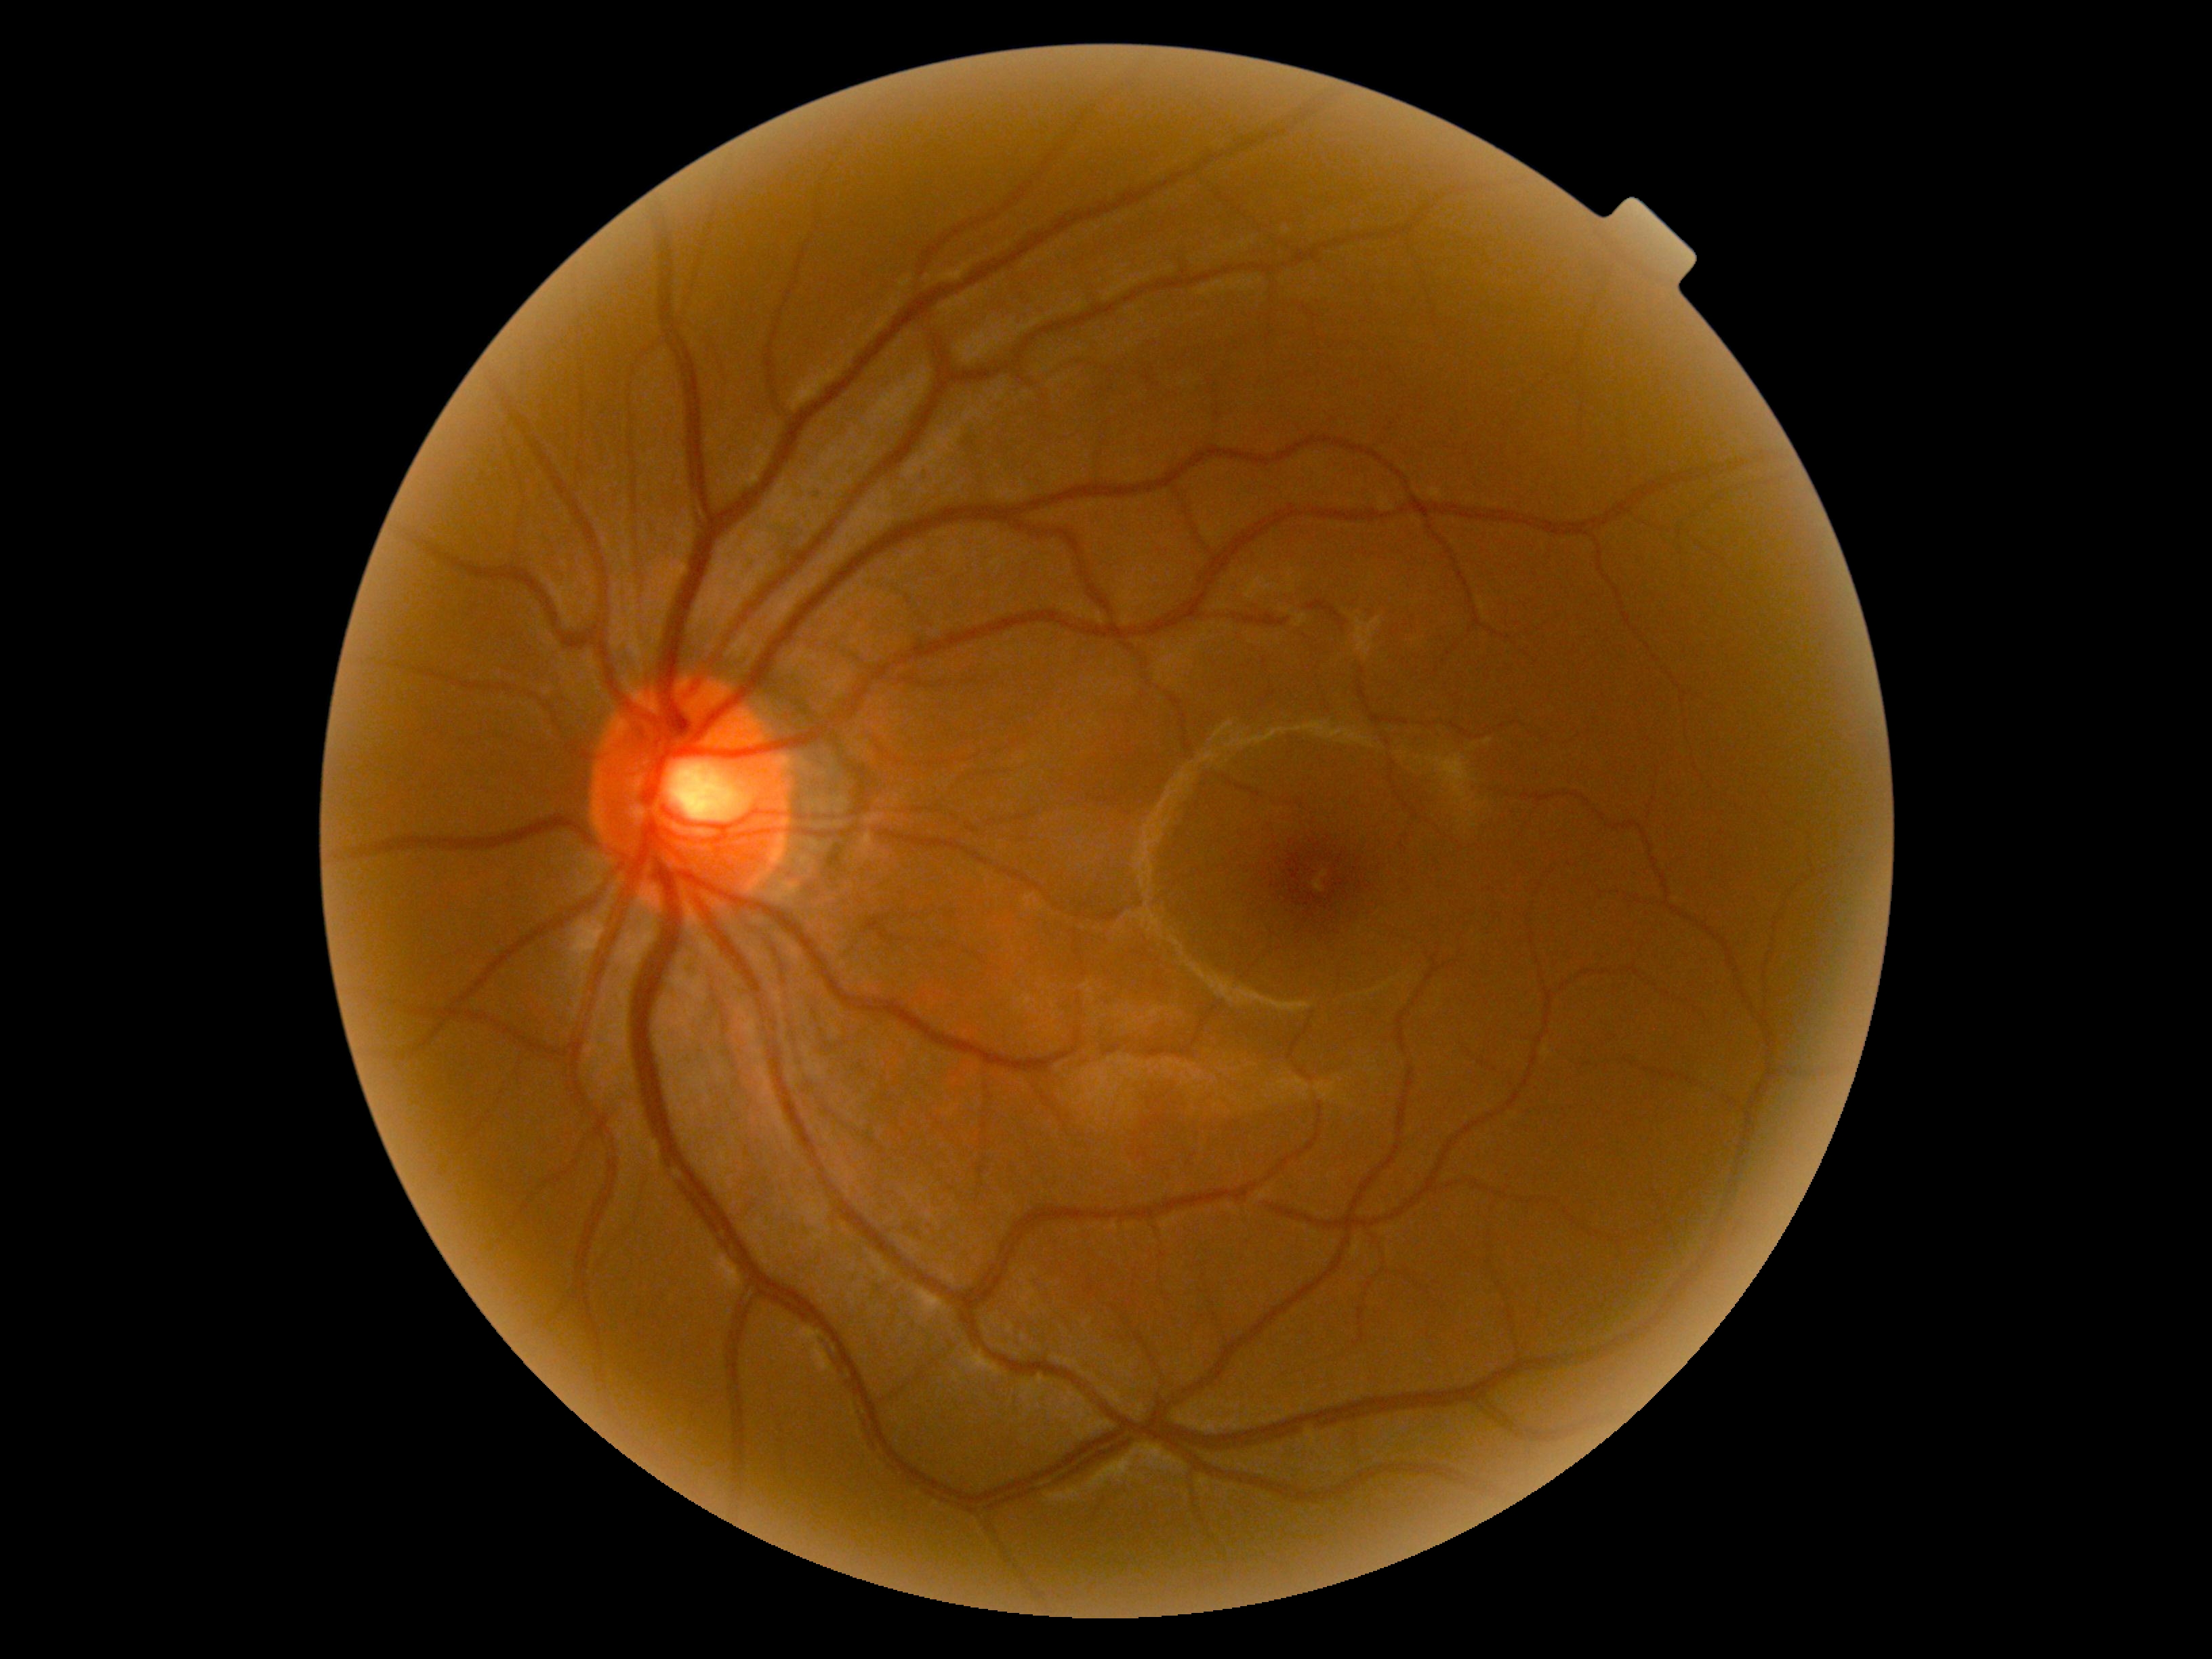

{
  "dr_grade": "no apparent retinopathy (grade 0)"
}